FOV: 45 degrees · color fundus image · NIDEK AFC-230 fundus camera · image size 848x848.
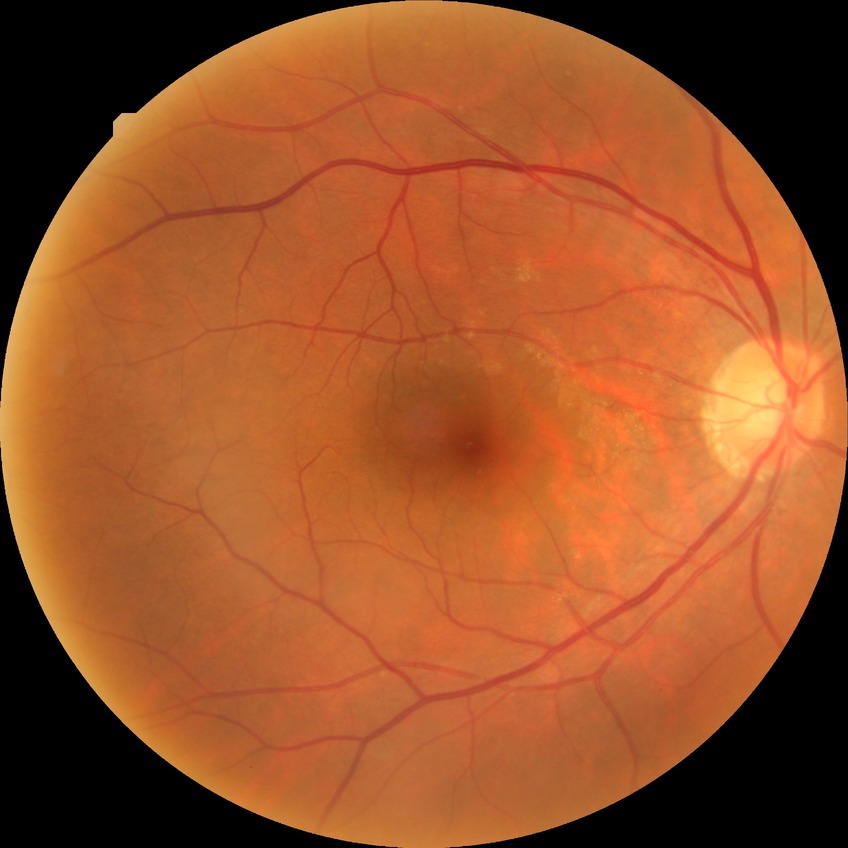

DR severity is SDR.